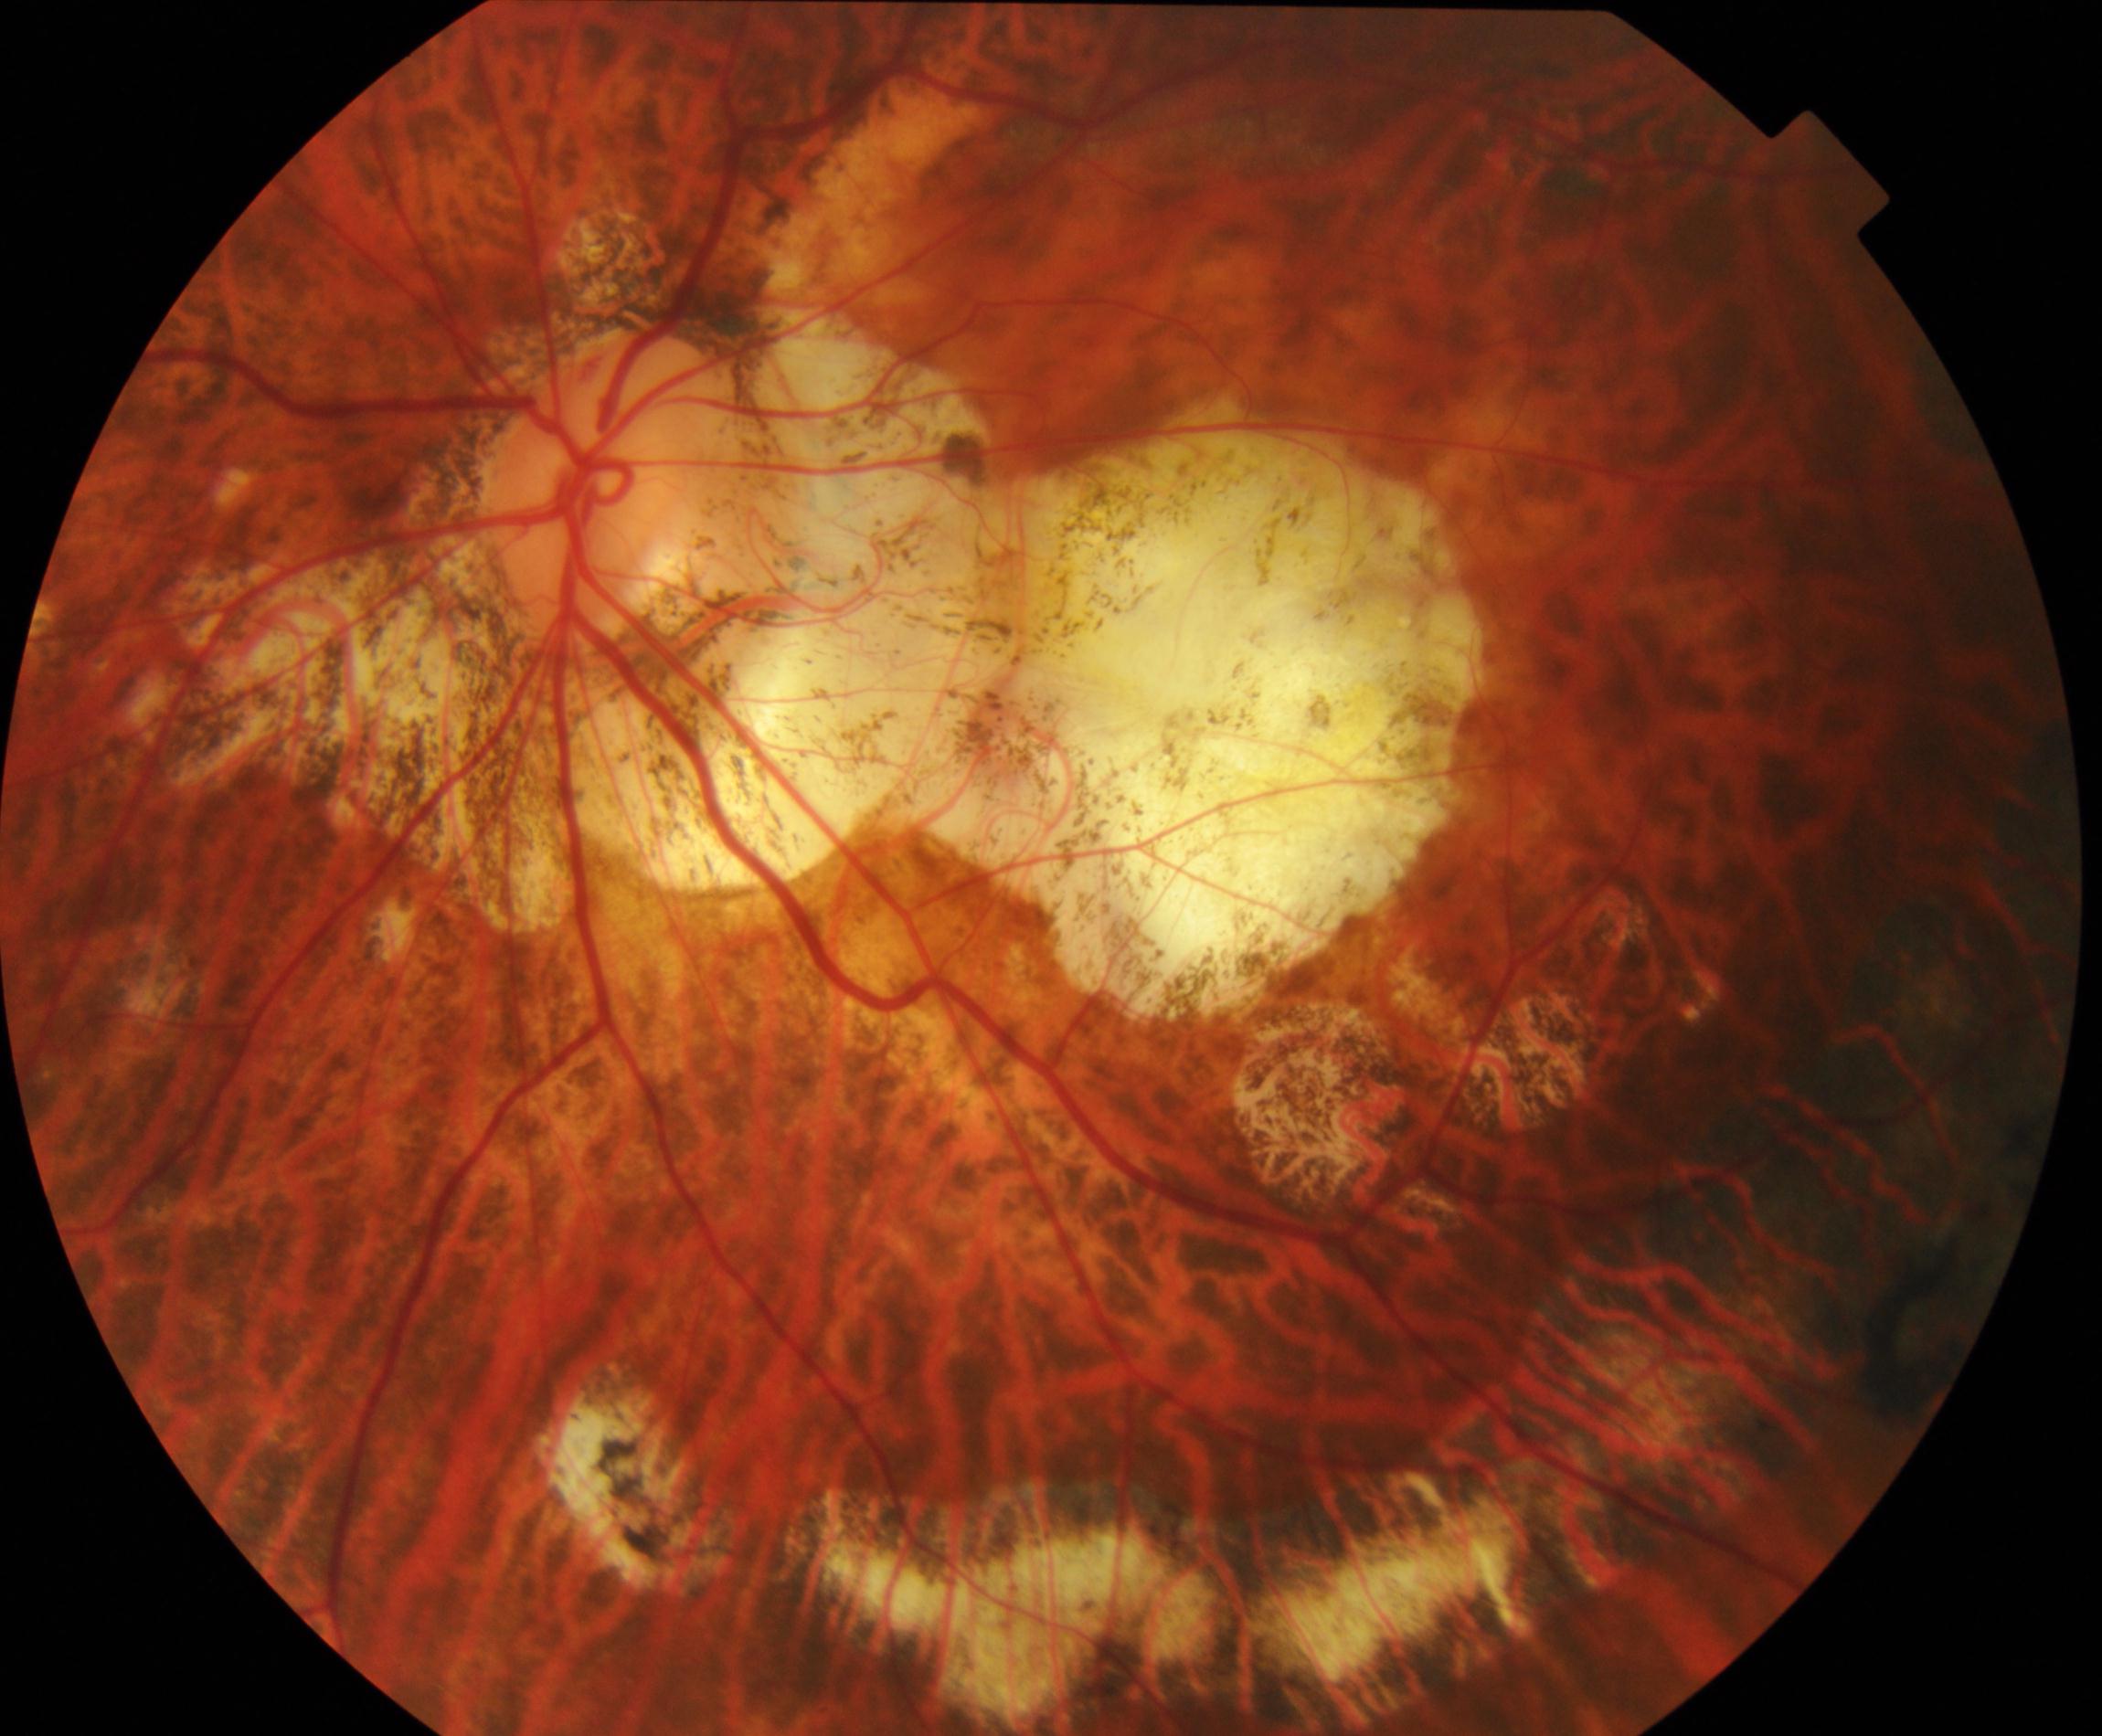
Retinal fundus photograph demonstrating pathological myopia.